45° field of view.
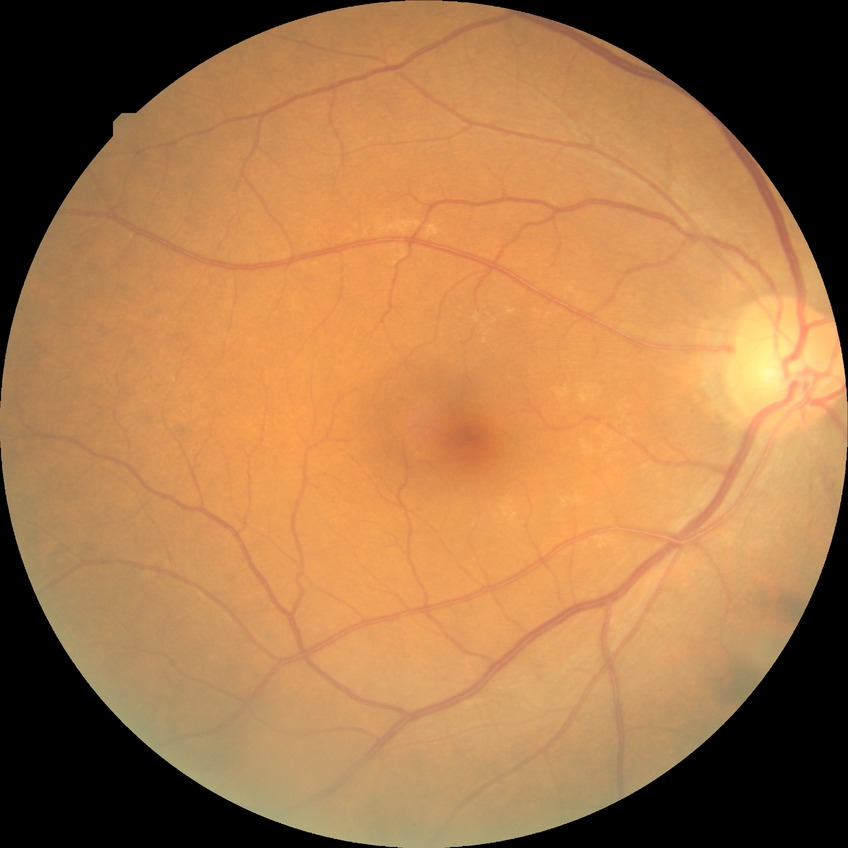
diabetic retinopathy (DR)@NDR (no diabetic retinopathy).